45° field of view. 848 by 848 pixels. NIDEK AFC-230. DR severity per modified Davis staging.
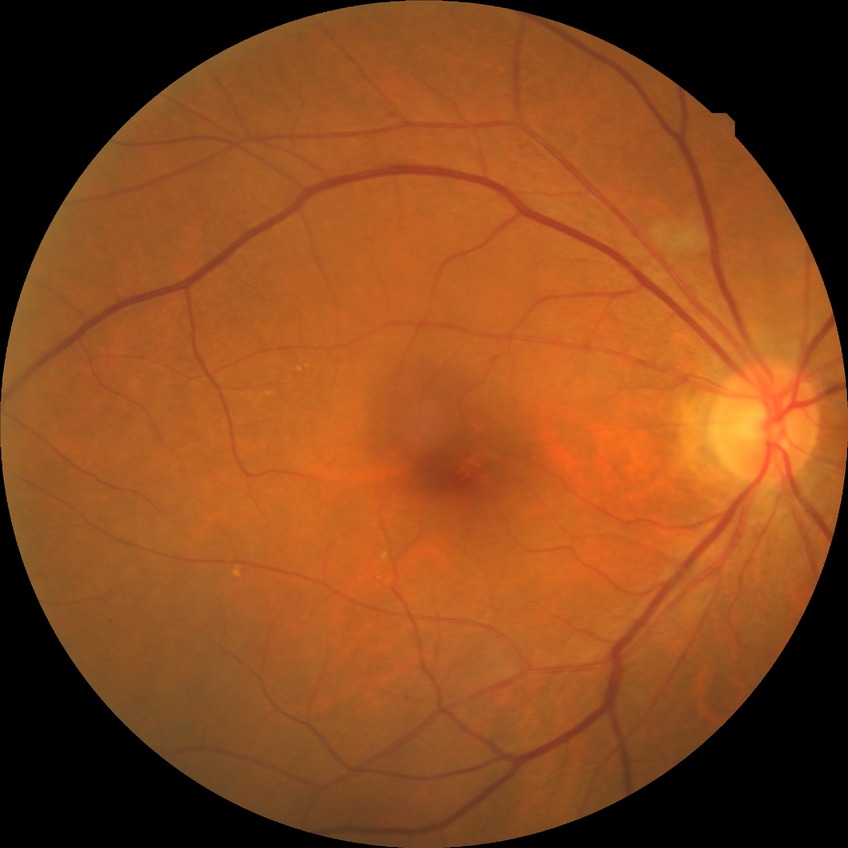
DR class: non-proliferative diabetic retinopathy.
DR is SDR.